45° field of view, 2352x1568px, CFP
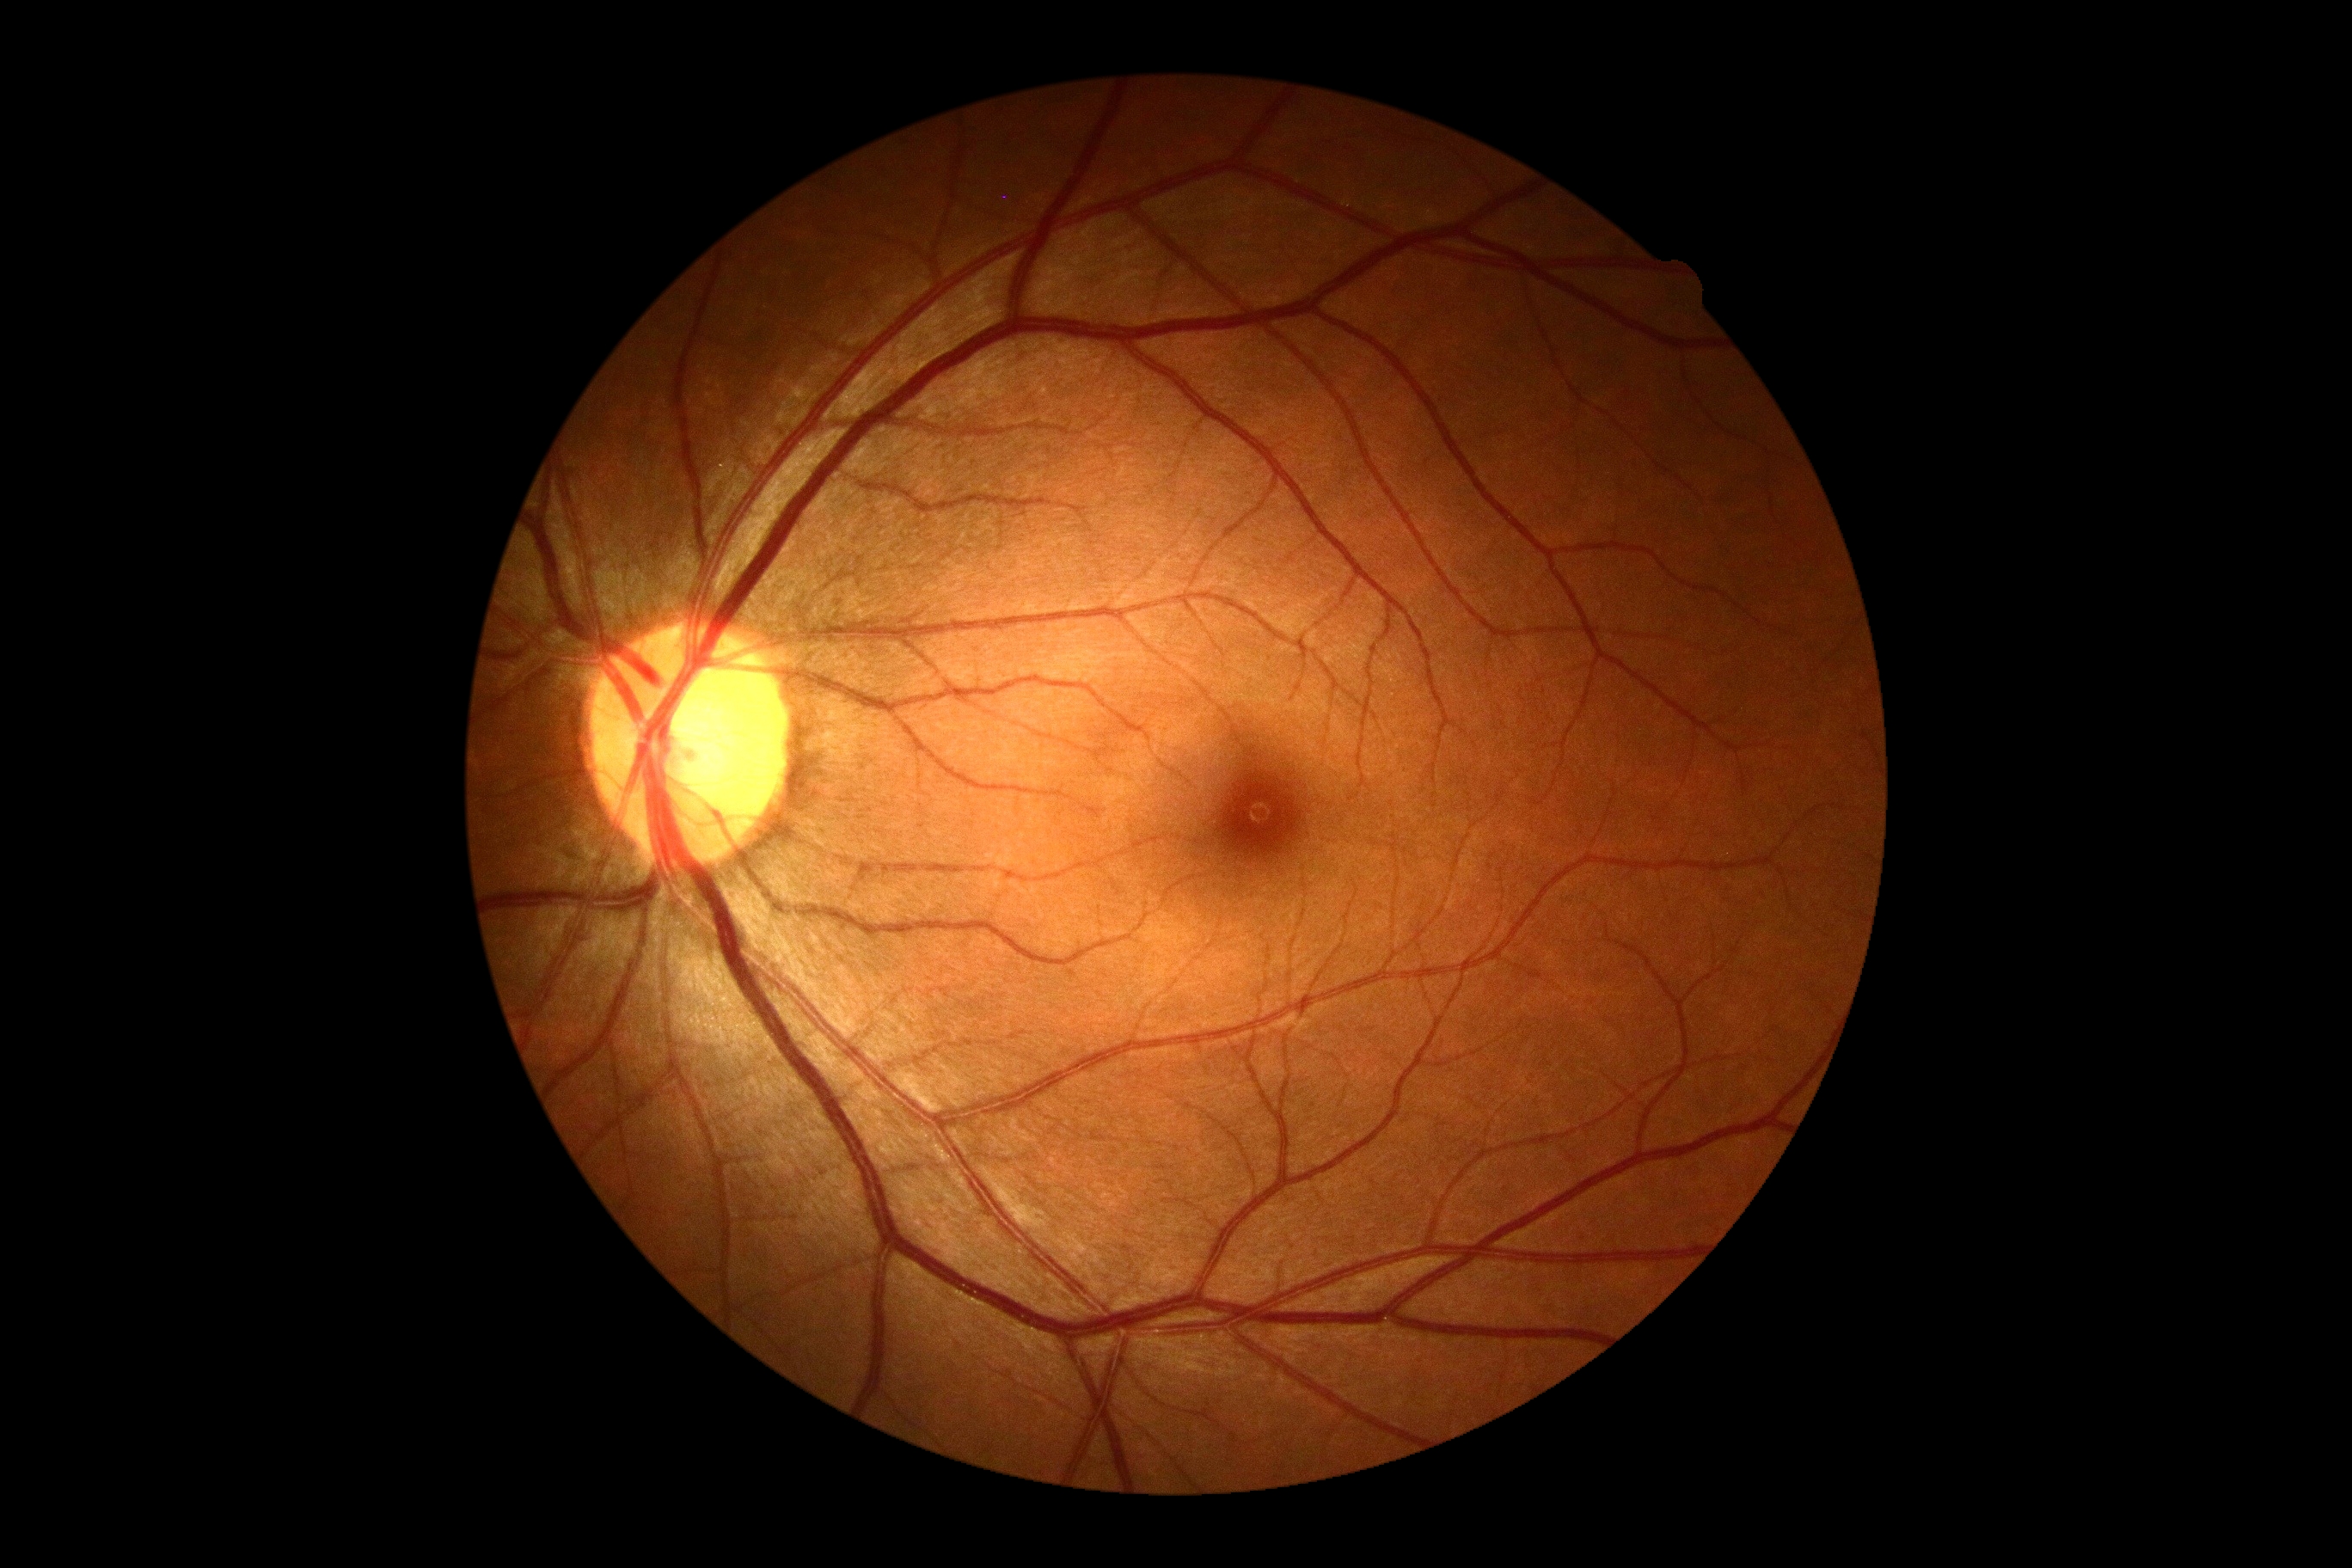

• diabetic retinopathy severity: grade 0 (no apparent retinopathy)
• DR impression: no apparent DR